Image size 848x848, CFP
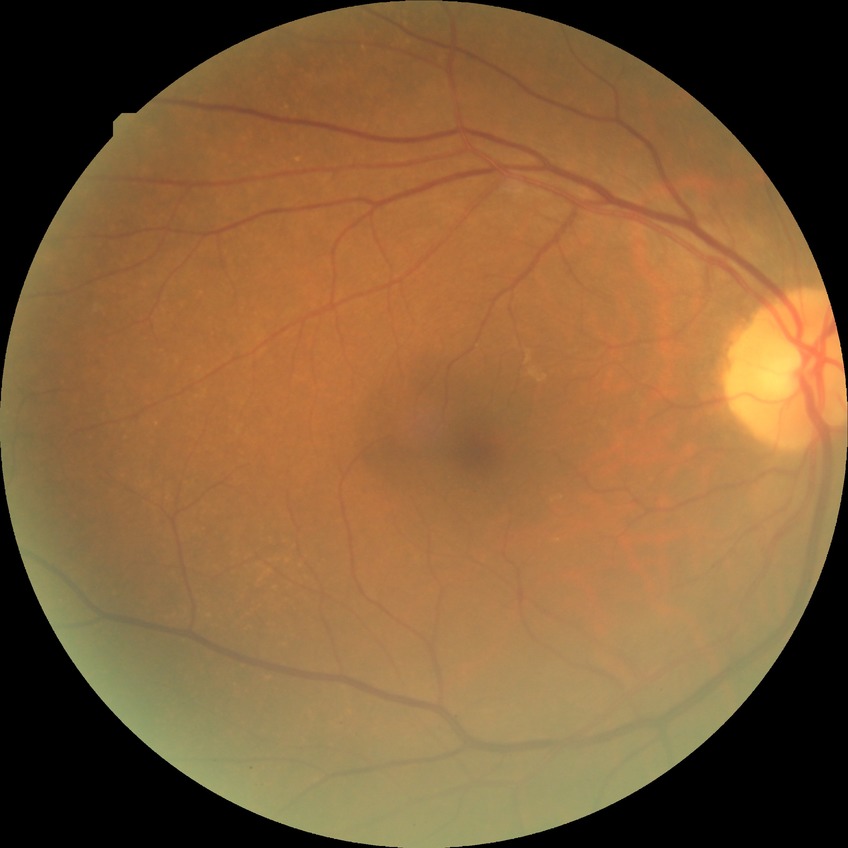 {"davis_grade": "NDR"}